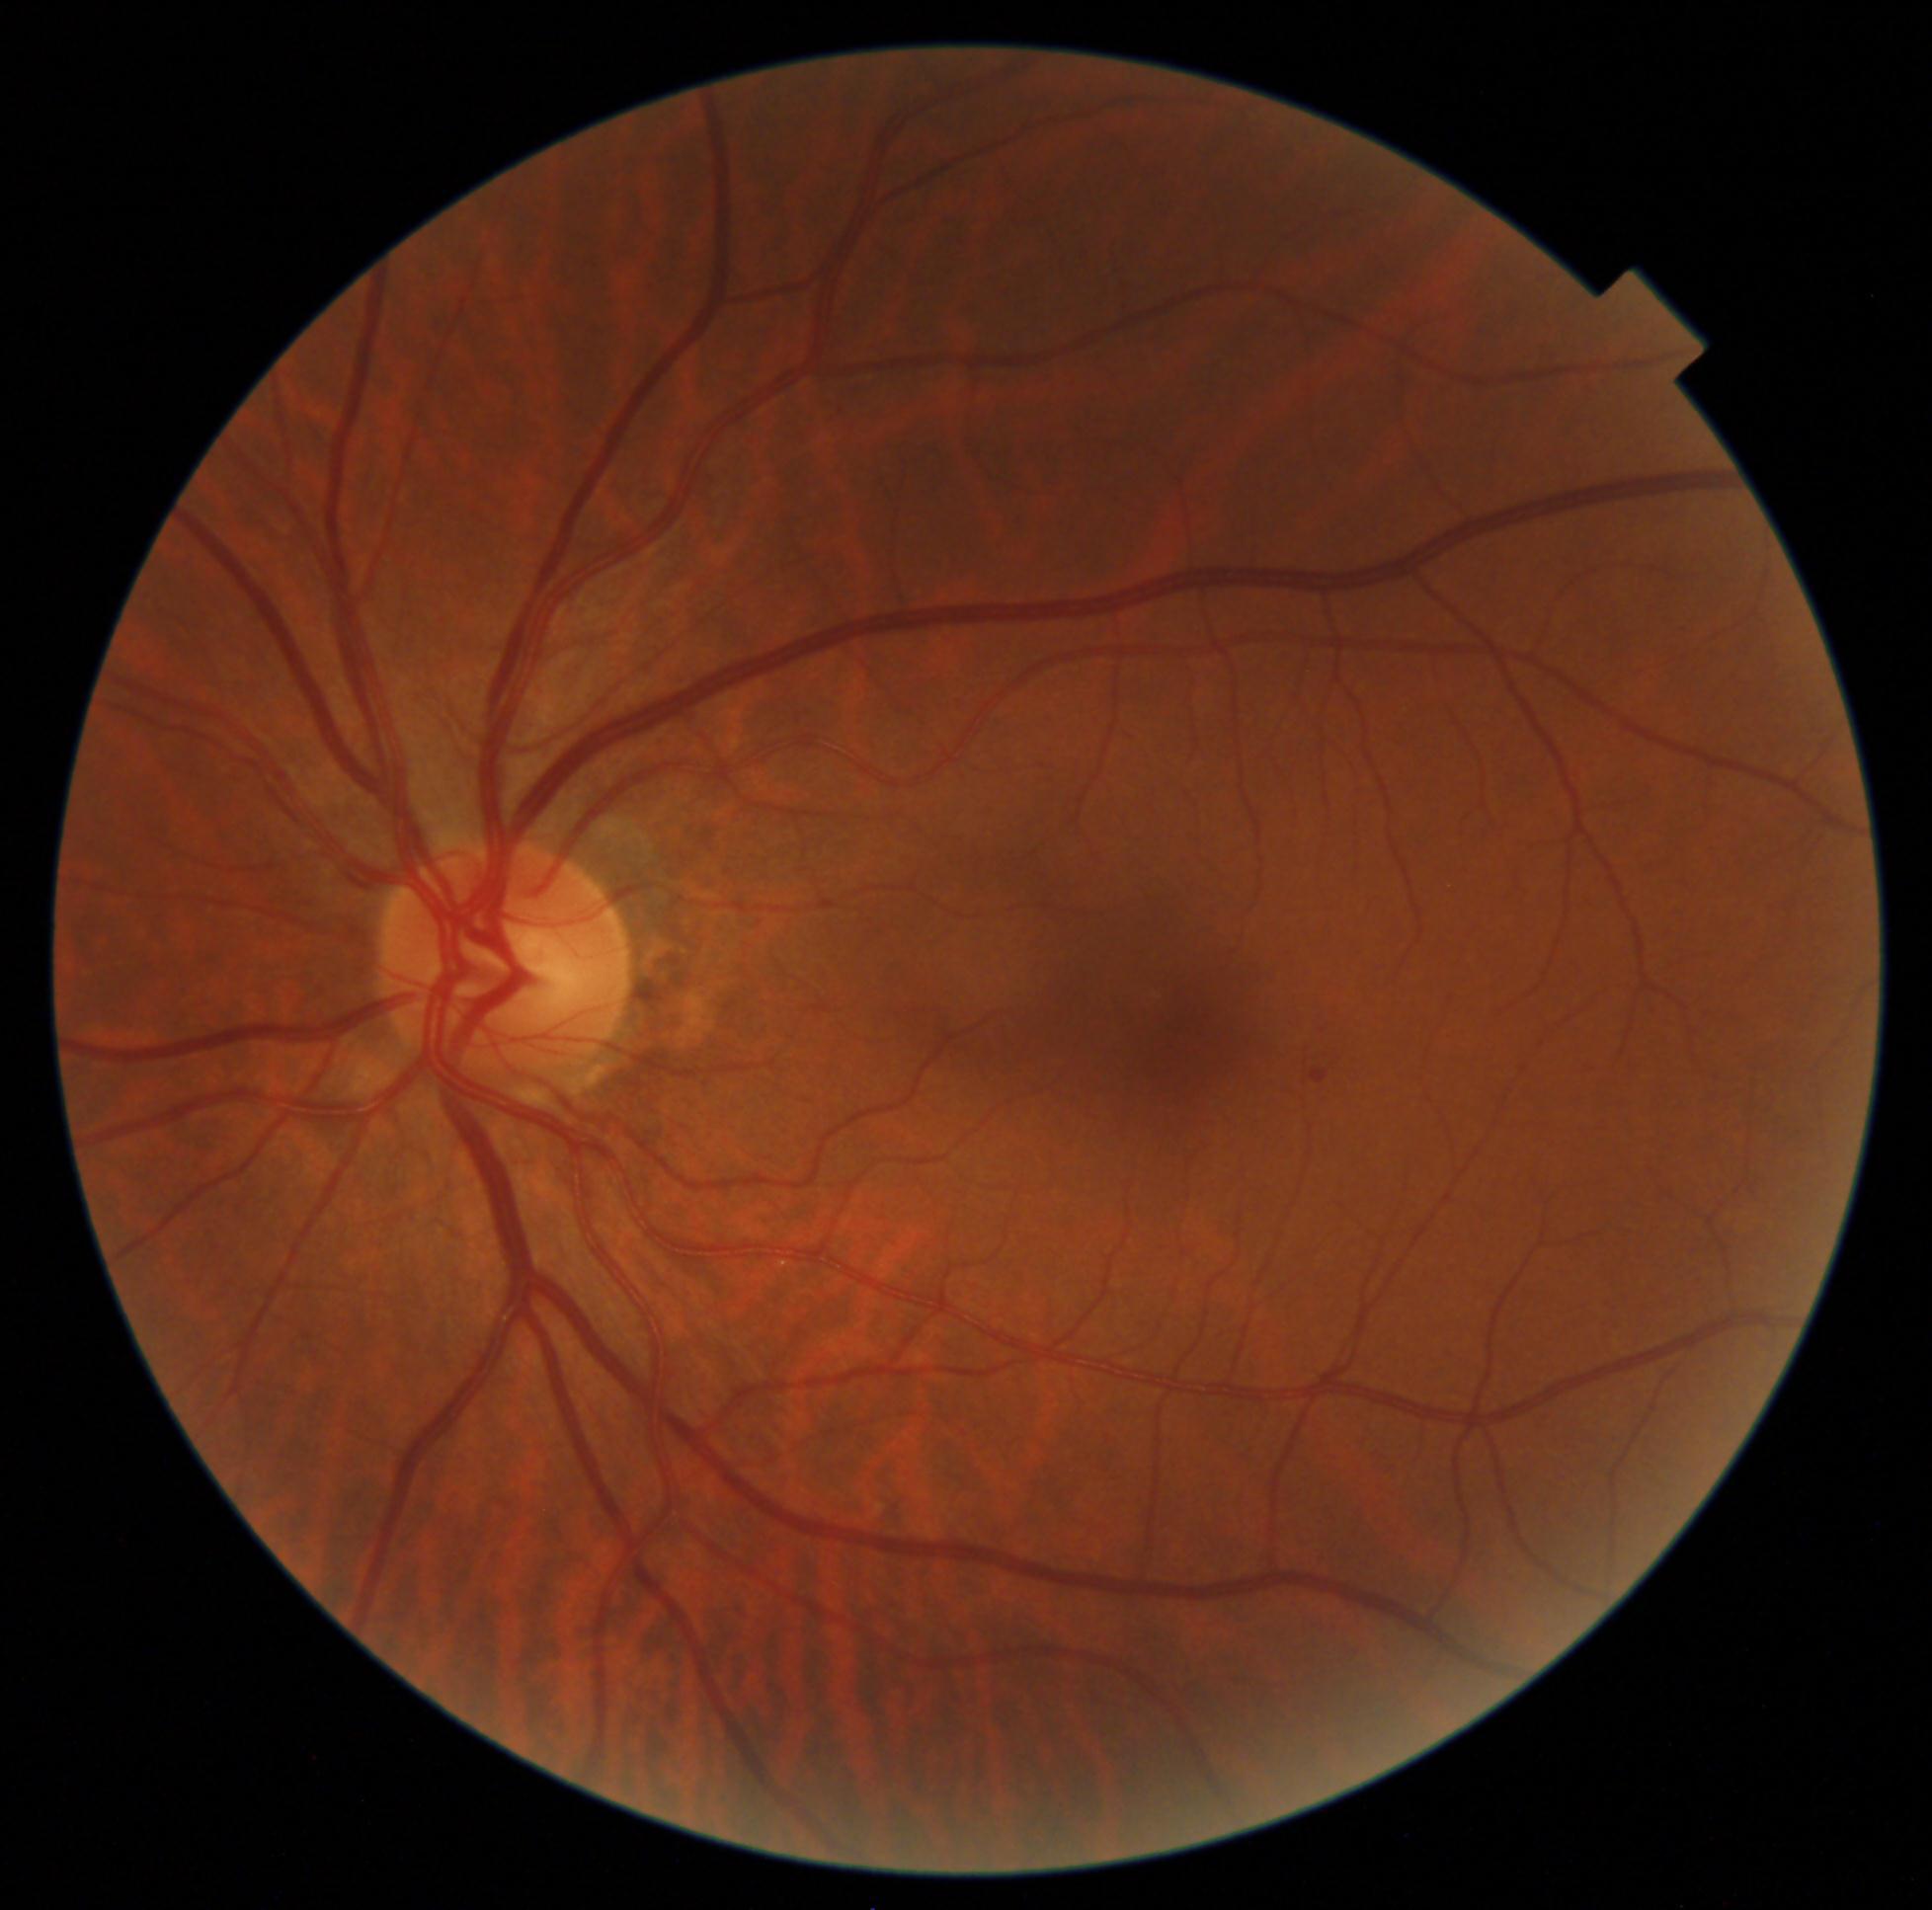 DR = 1 — presence of microaneurysms only